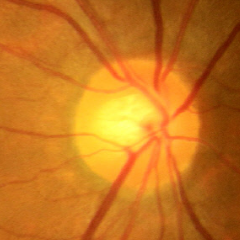

Impression = no glaucomatous optic neuropathy.